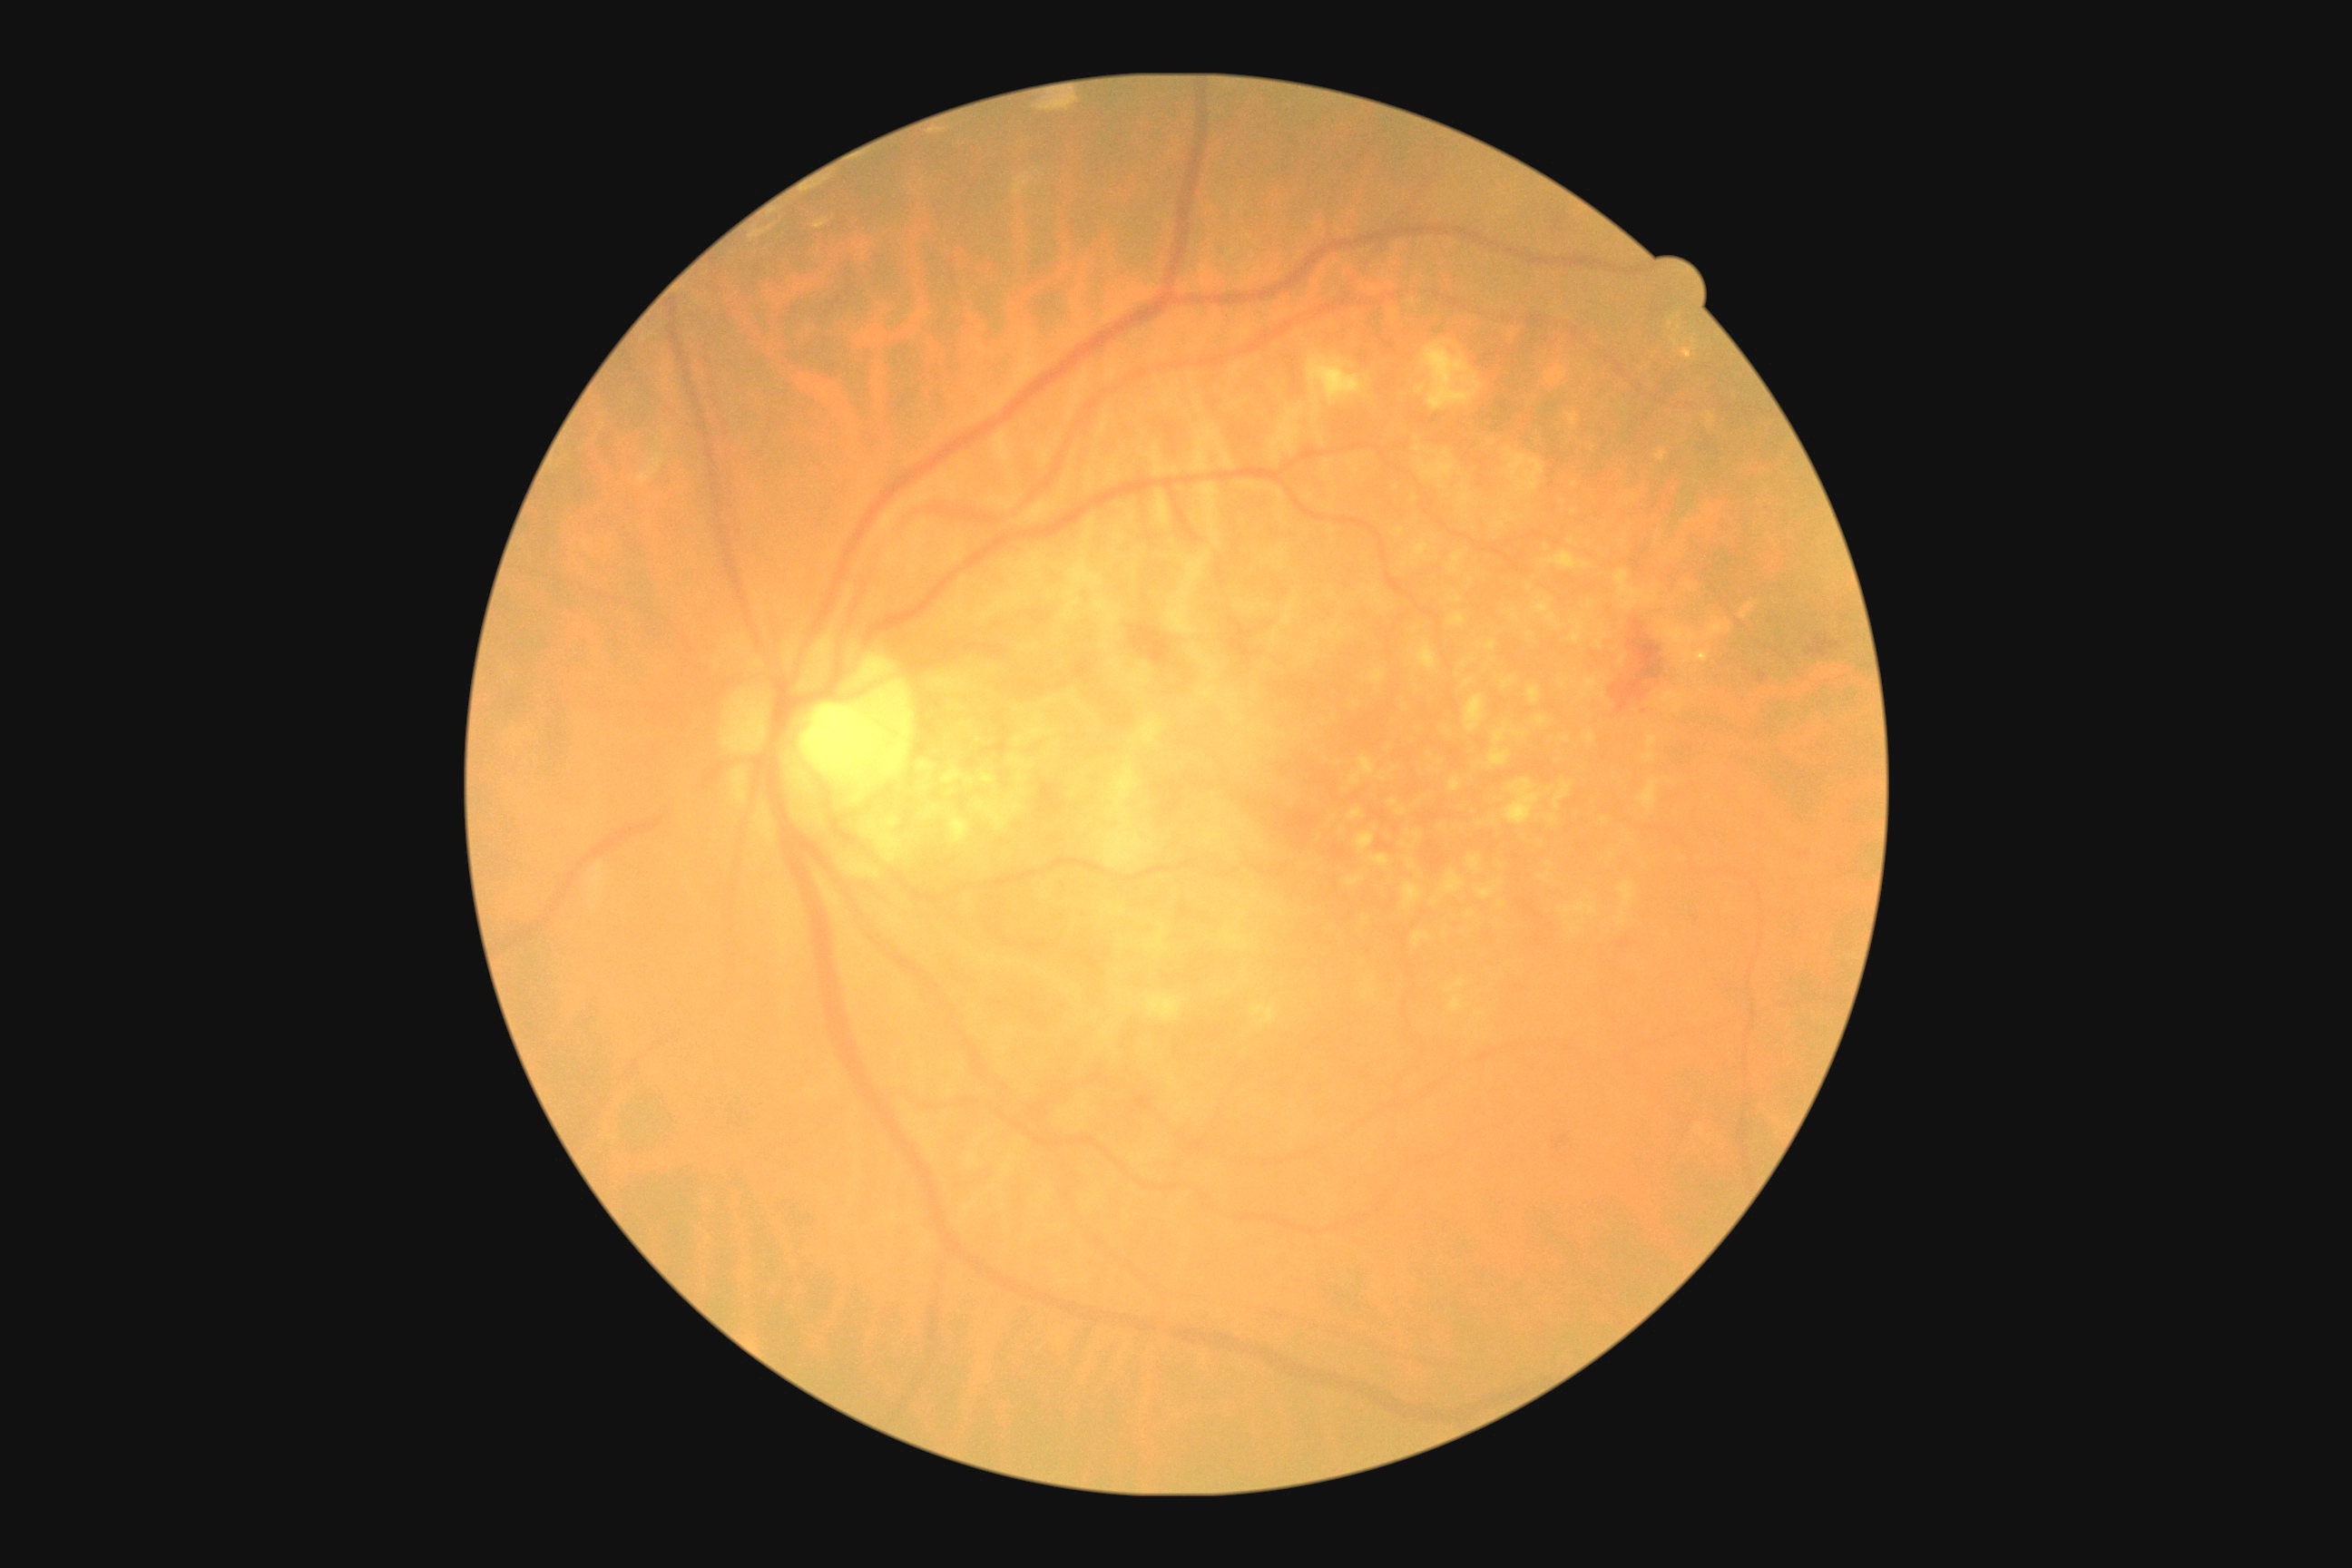

  dr_category: non-proliferative diabetic retinopathy
  dr_grade: 2 (moderate NPDR)